Camera: NIDEK AFC-230. Nonmydriatic. Graded on the modified Davis scale: 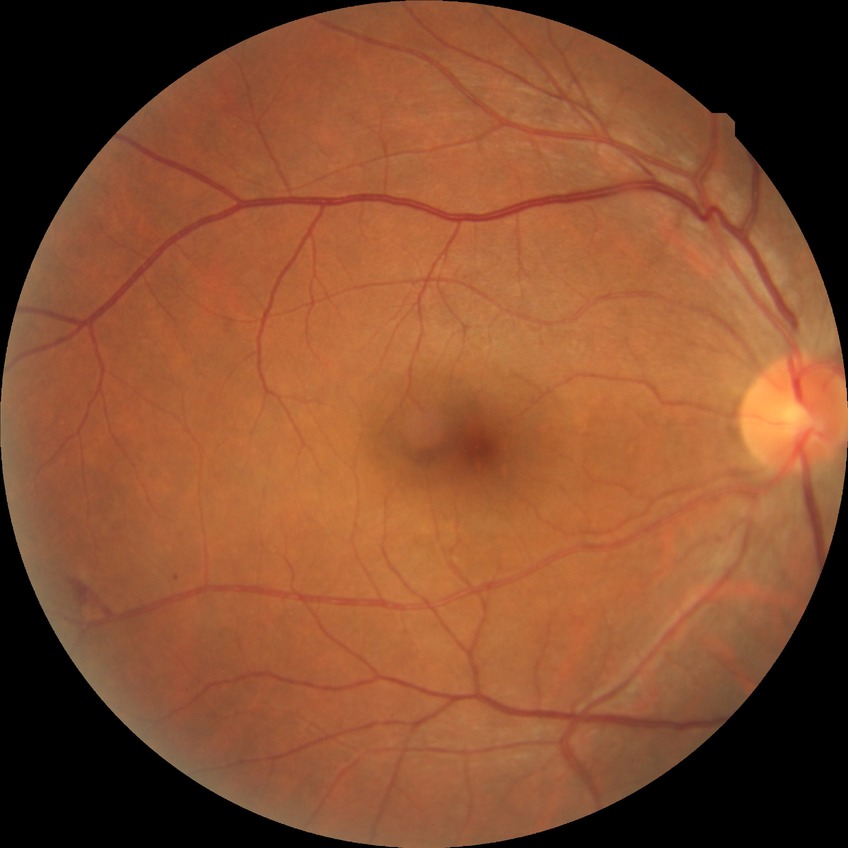 diabetic retinopathy (DR): NDR (no diabetic retinopathy).